Posterior pole photograph — 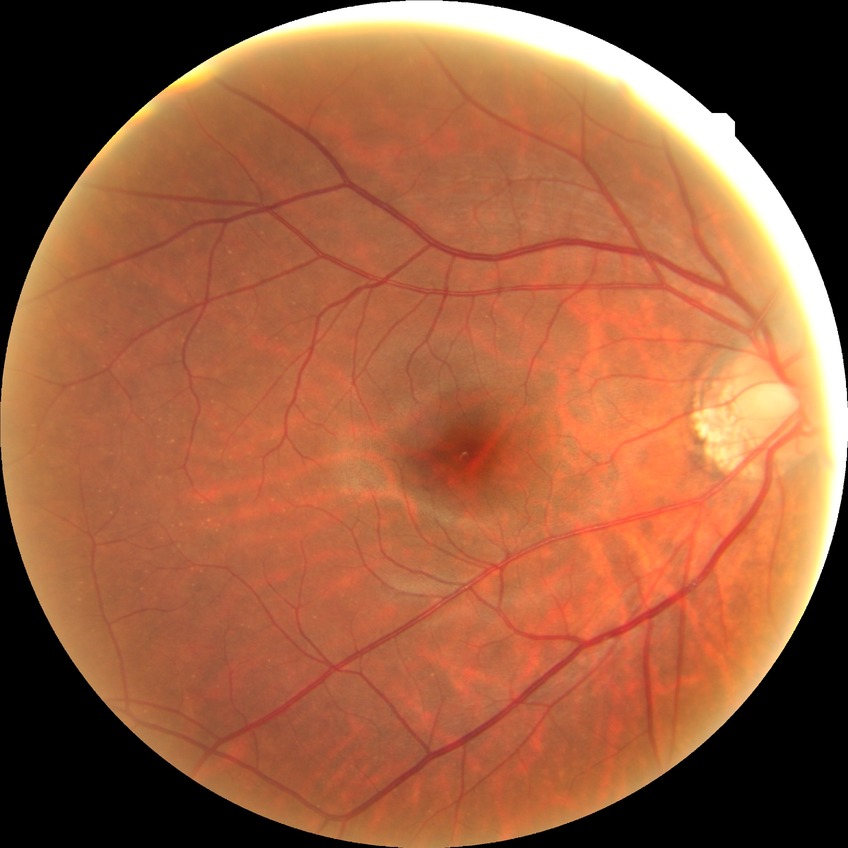 DR grade: NDR.
No signs of diabetic retinopathy.